2212 x 1659 pixels · 45-degree field of view: 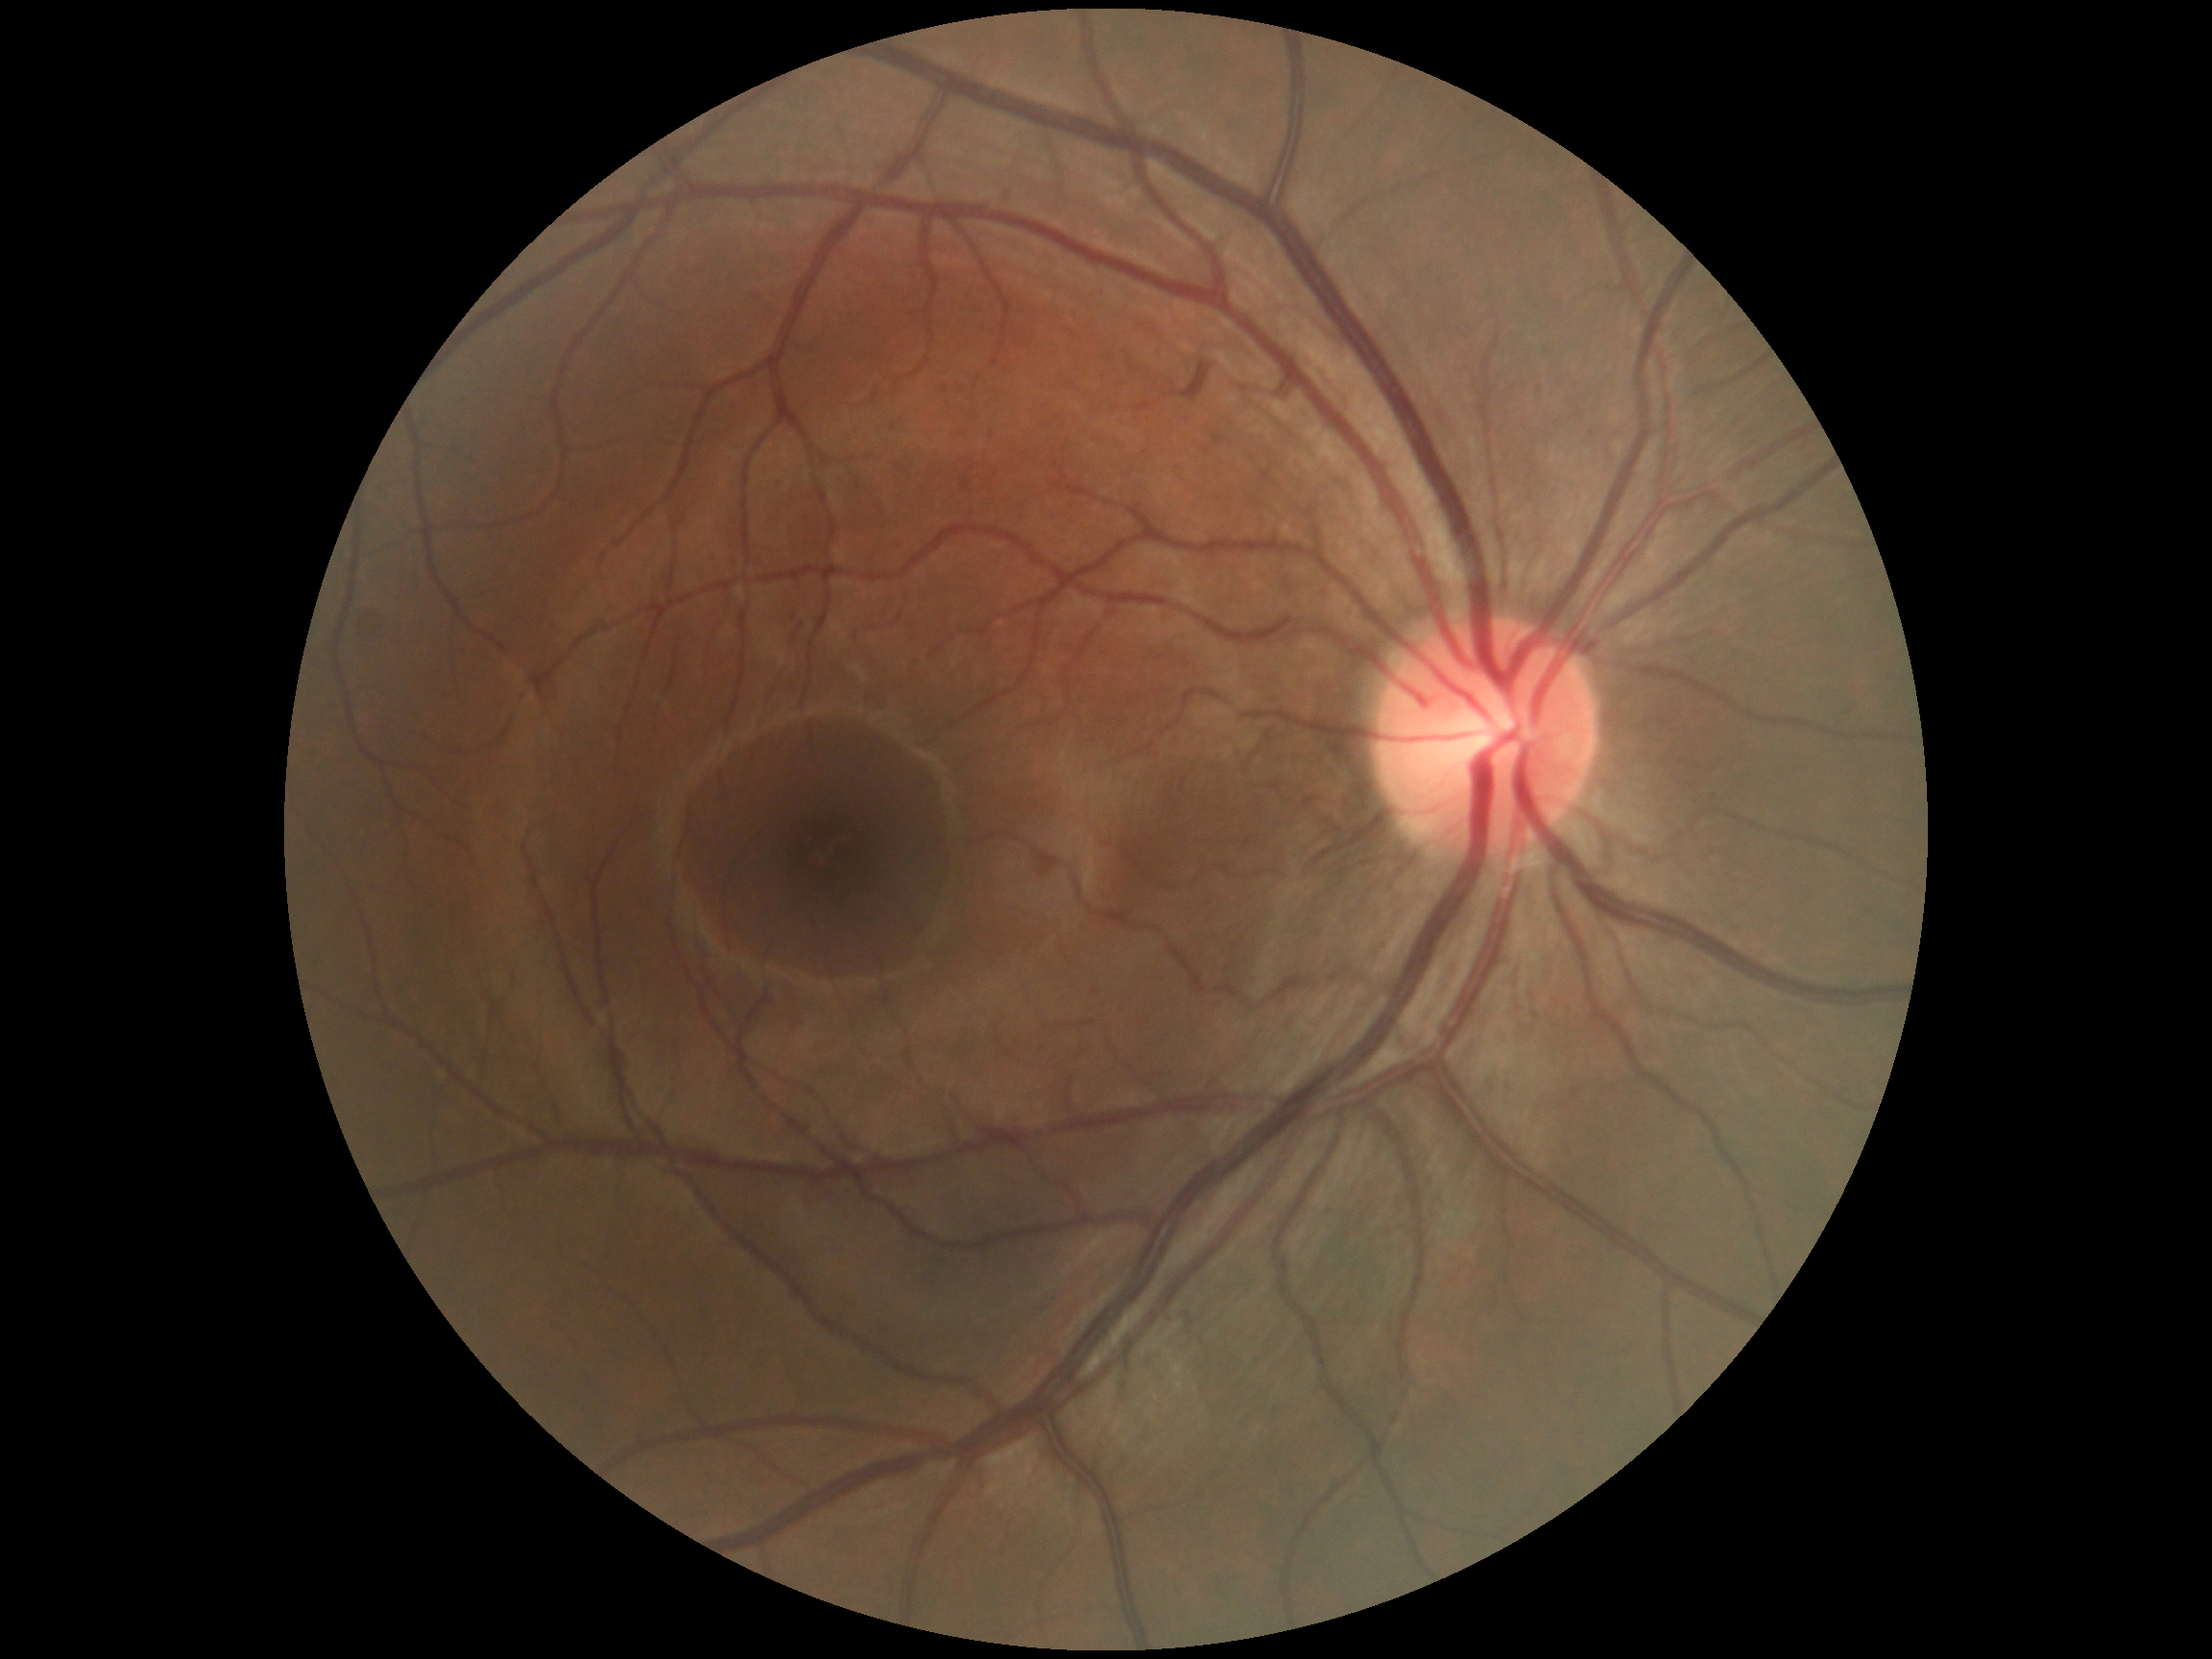
diabetic retinopathy = no apparent diabetic retinopathy (grade 0).